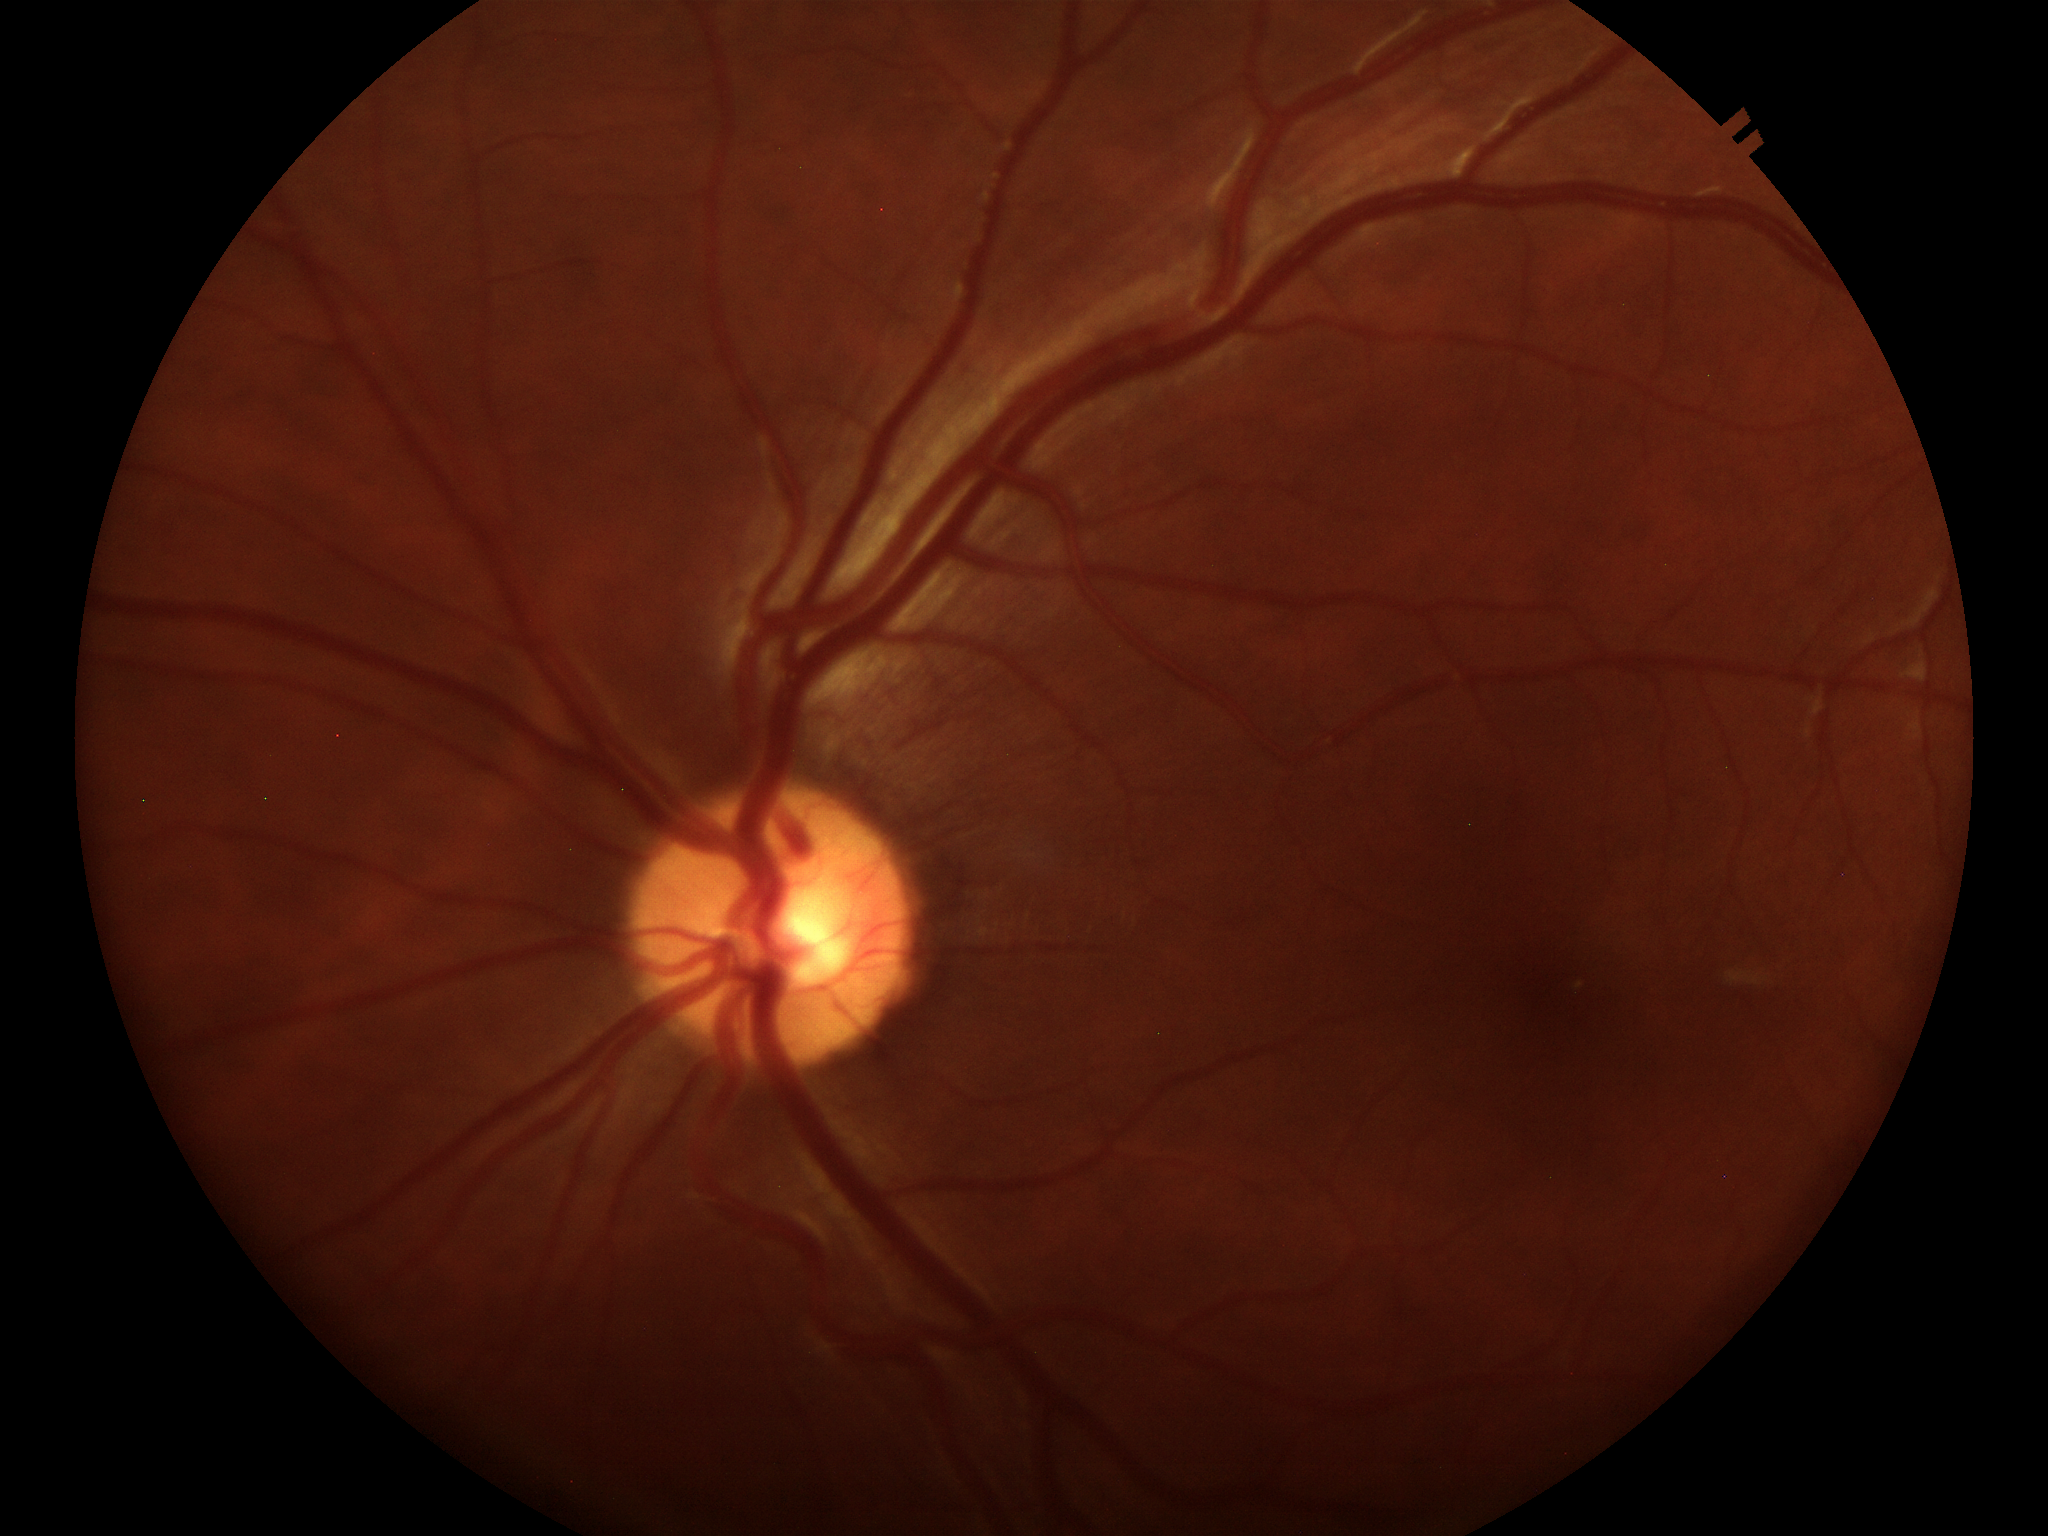 vertical cup-to-disc ratio (VCDR)=0.51
horizontal cup-disc ratio (HCDR)=0.52
Glaucoma assessment=not suspect